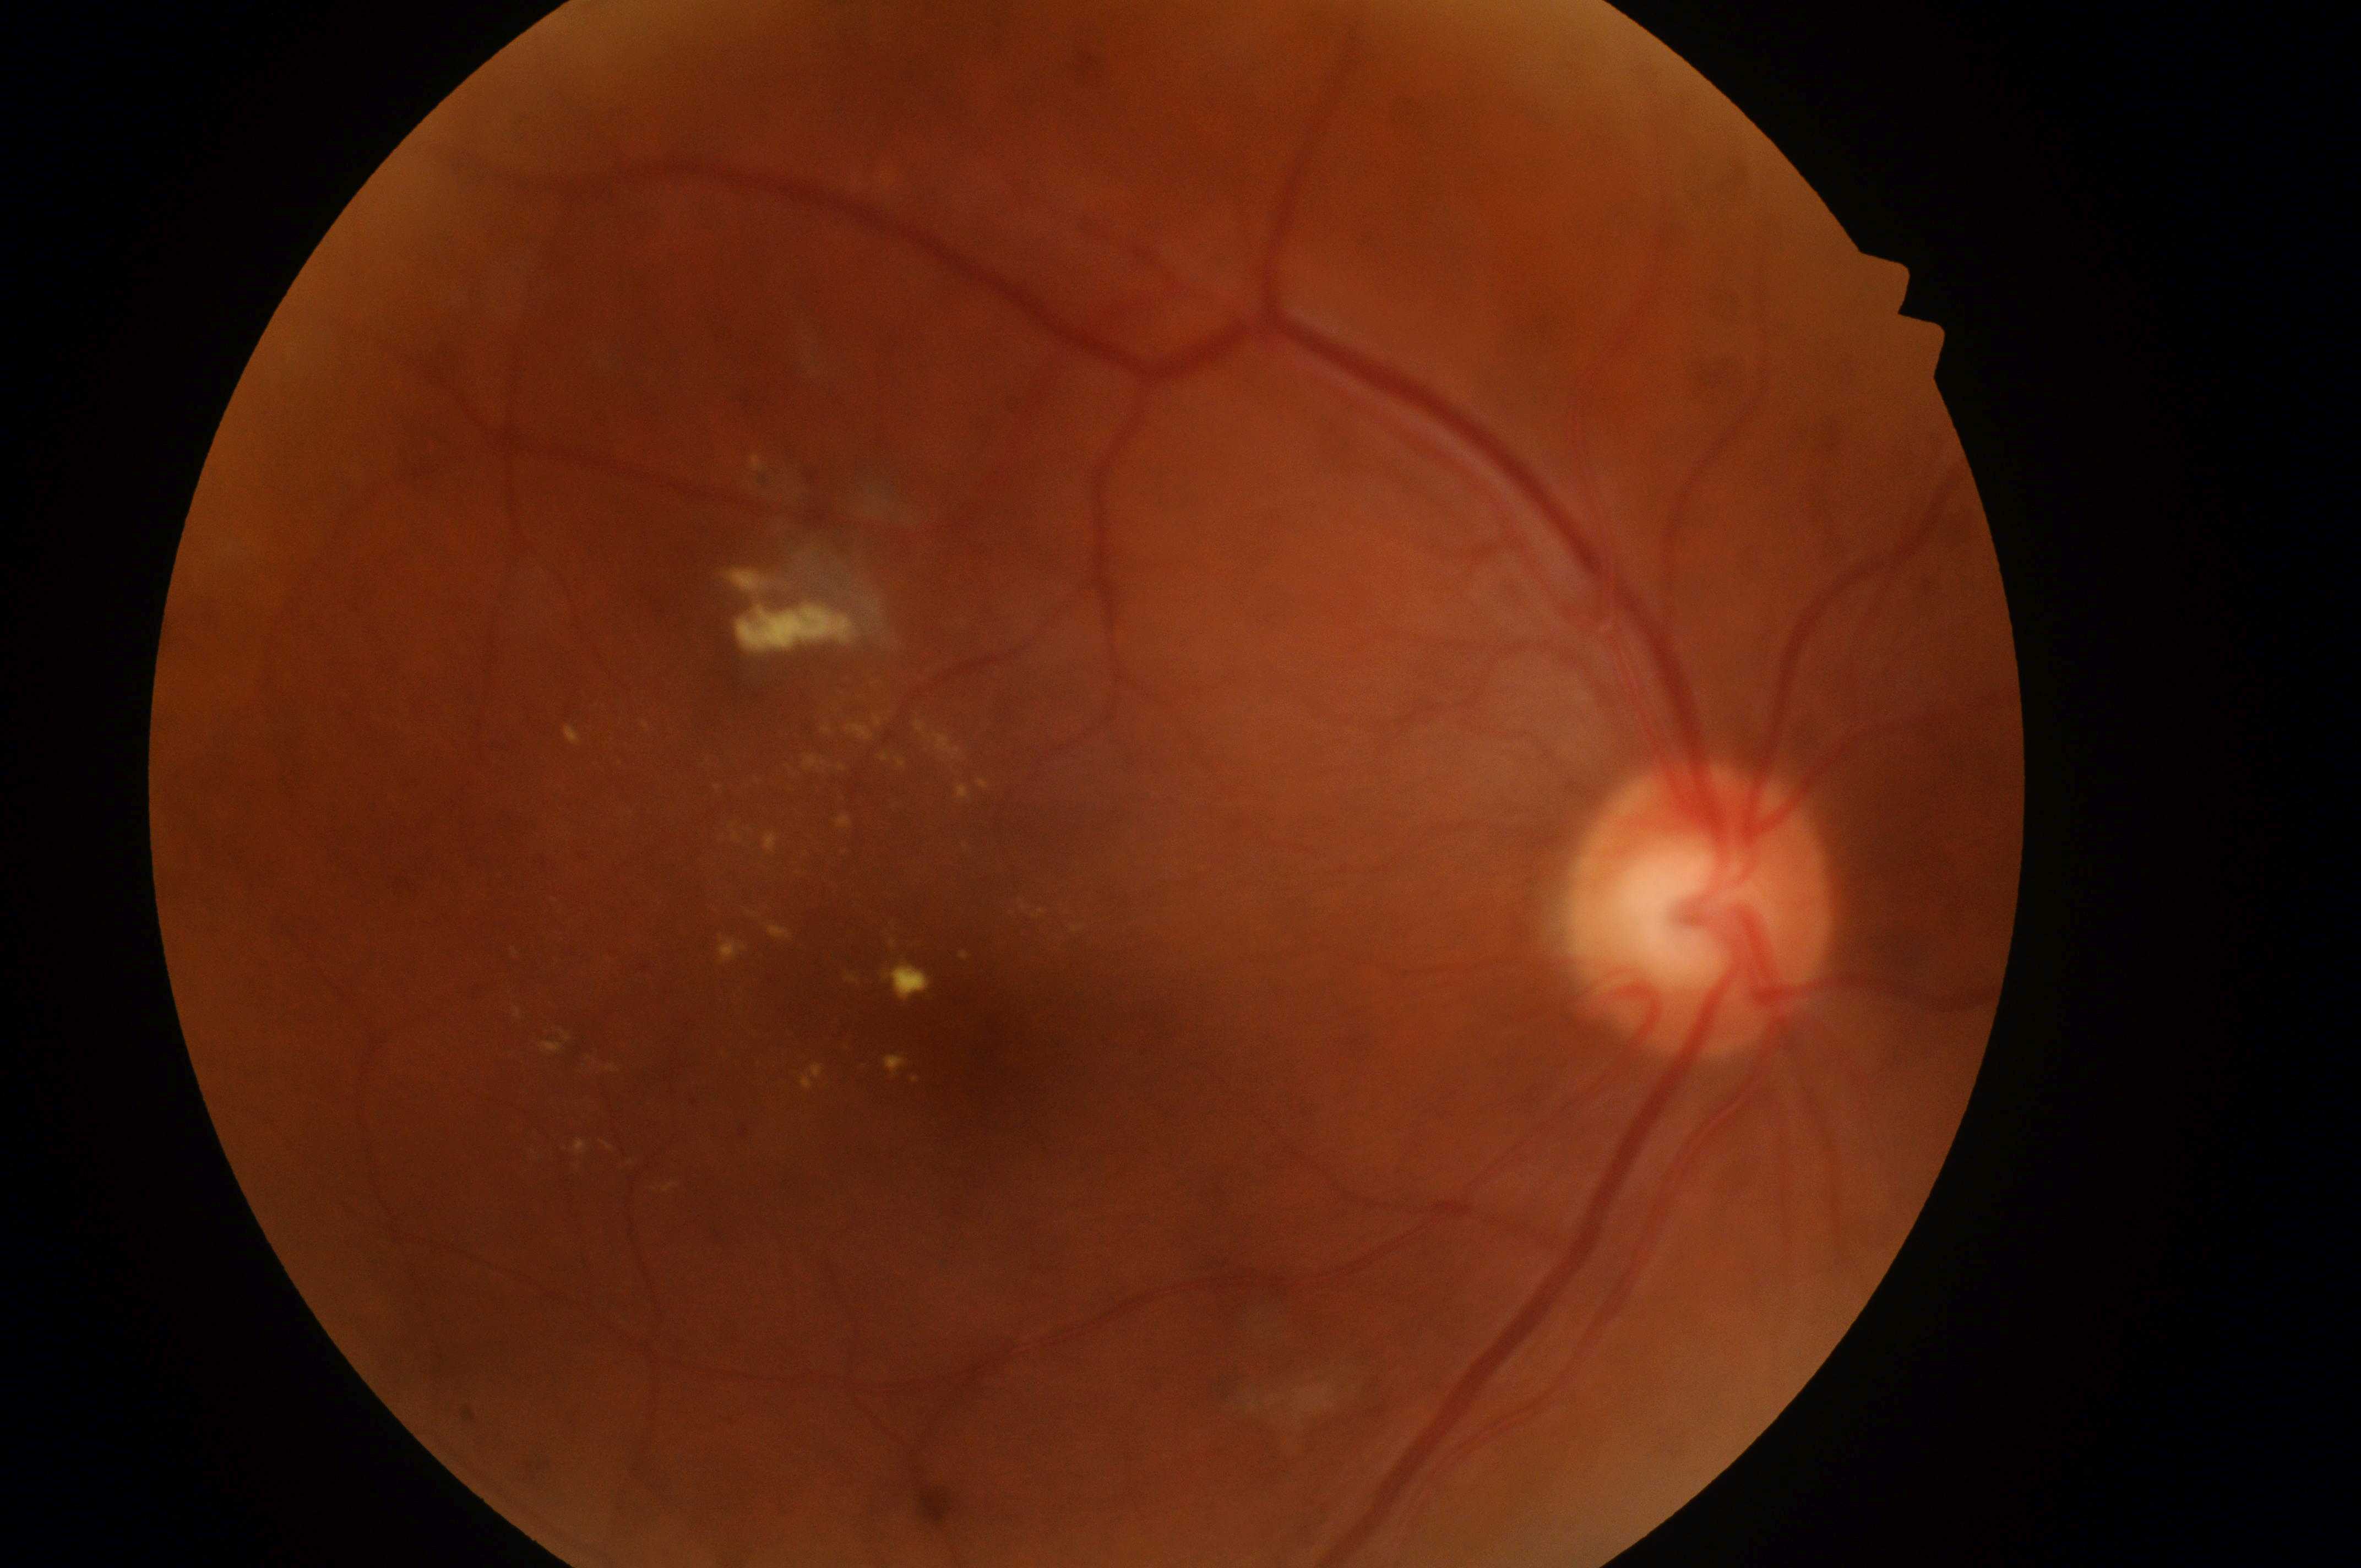 non-proliferative diabetic retinopathy; OD; diabetic retinopathy (DR)=grade 2 (moderate NPDR); diabetic macular edema (DME)=high risk (grade 2); fovea=977, 1055; the optic disc=1700, 922.